240 by 240 pixels. Optic nerve head crop. Camera: Nidek AFC-330 — 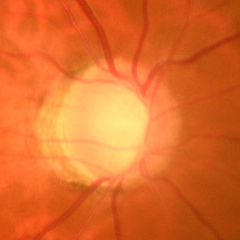

Glaucoma is present. Glaucoma assessment = early glaucomatous changes.